848 by 848 pixels · FOV: 45 degrees · retinal fundus photograph · modified Davis grading — 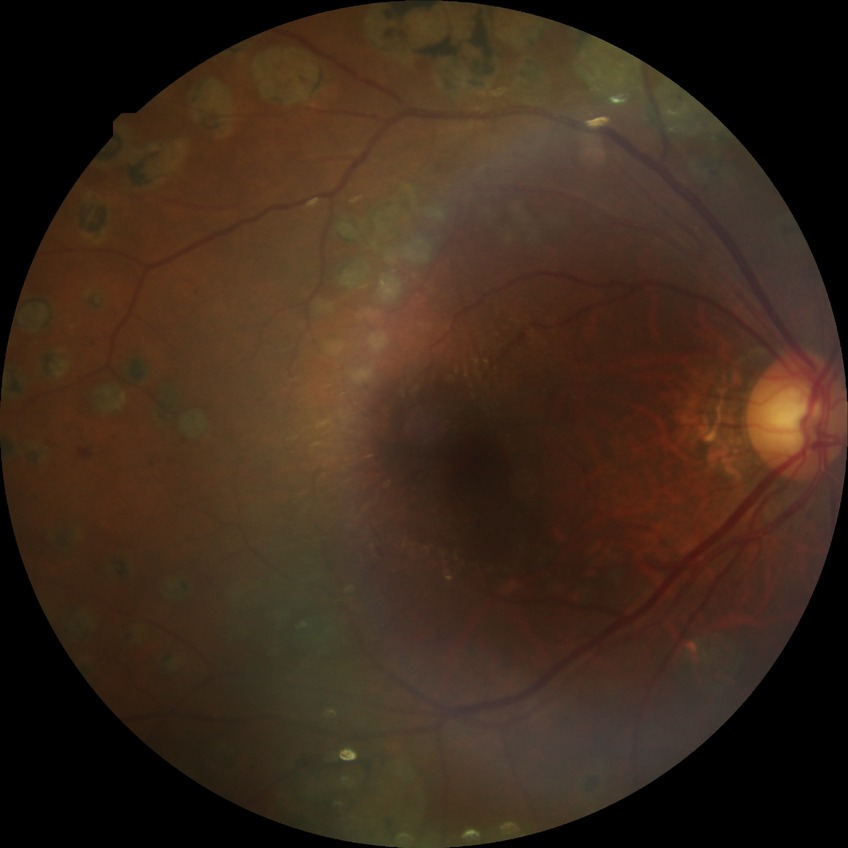 {"davis_grade": "PDR"}